Fundus photo
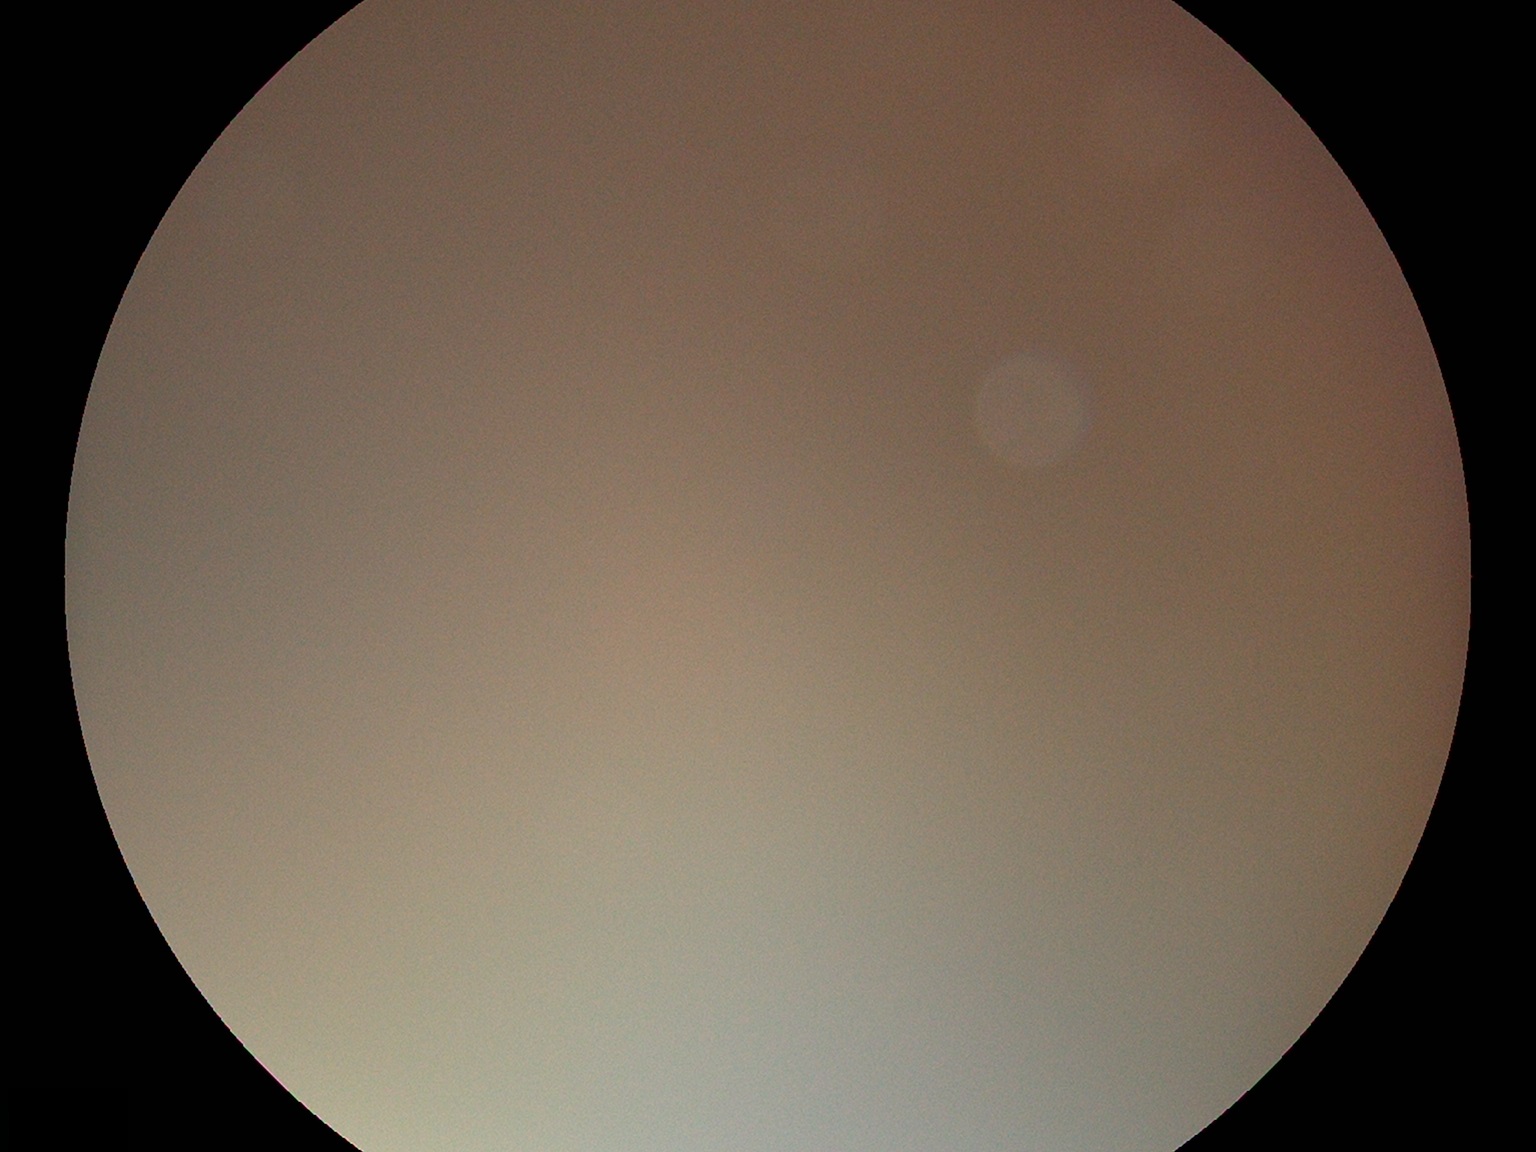

Ungradable image — DR severity cannot be determined. Diabetic retinopathy is ungradable due to poor image quality.